1932 by 1932 pixels; retinal fundus photograph:
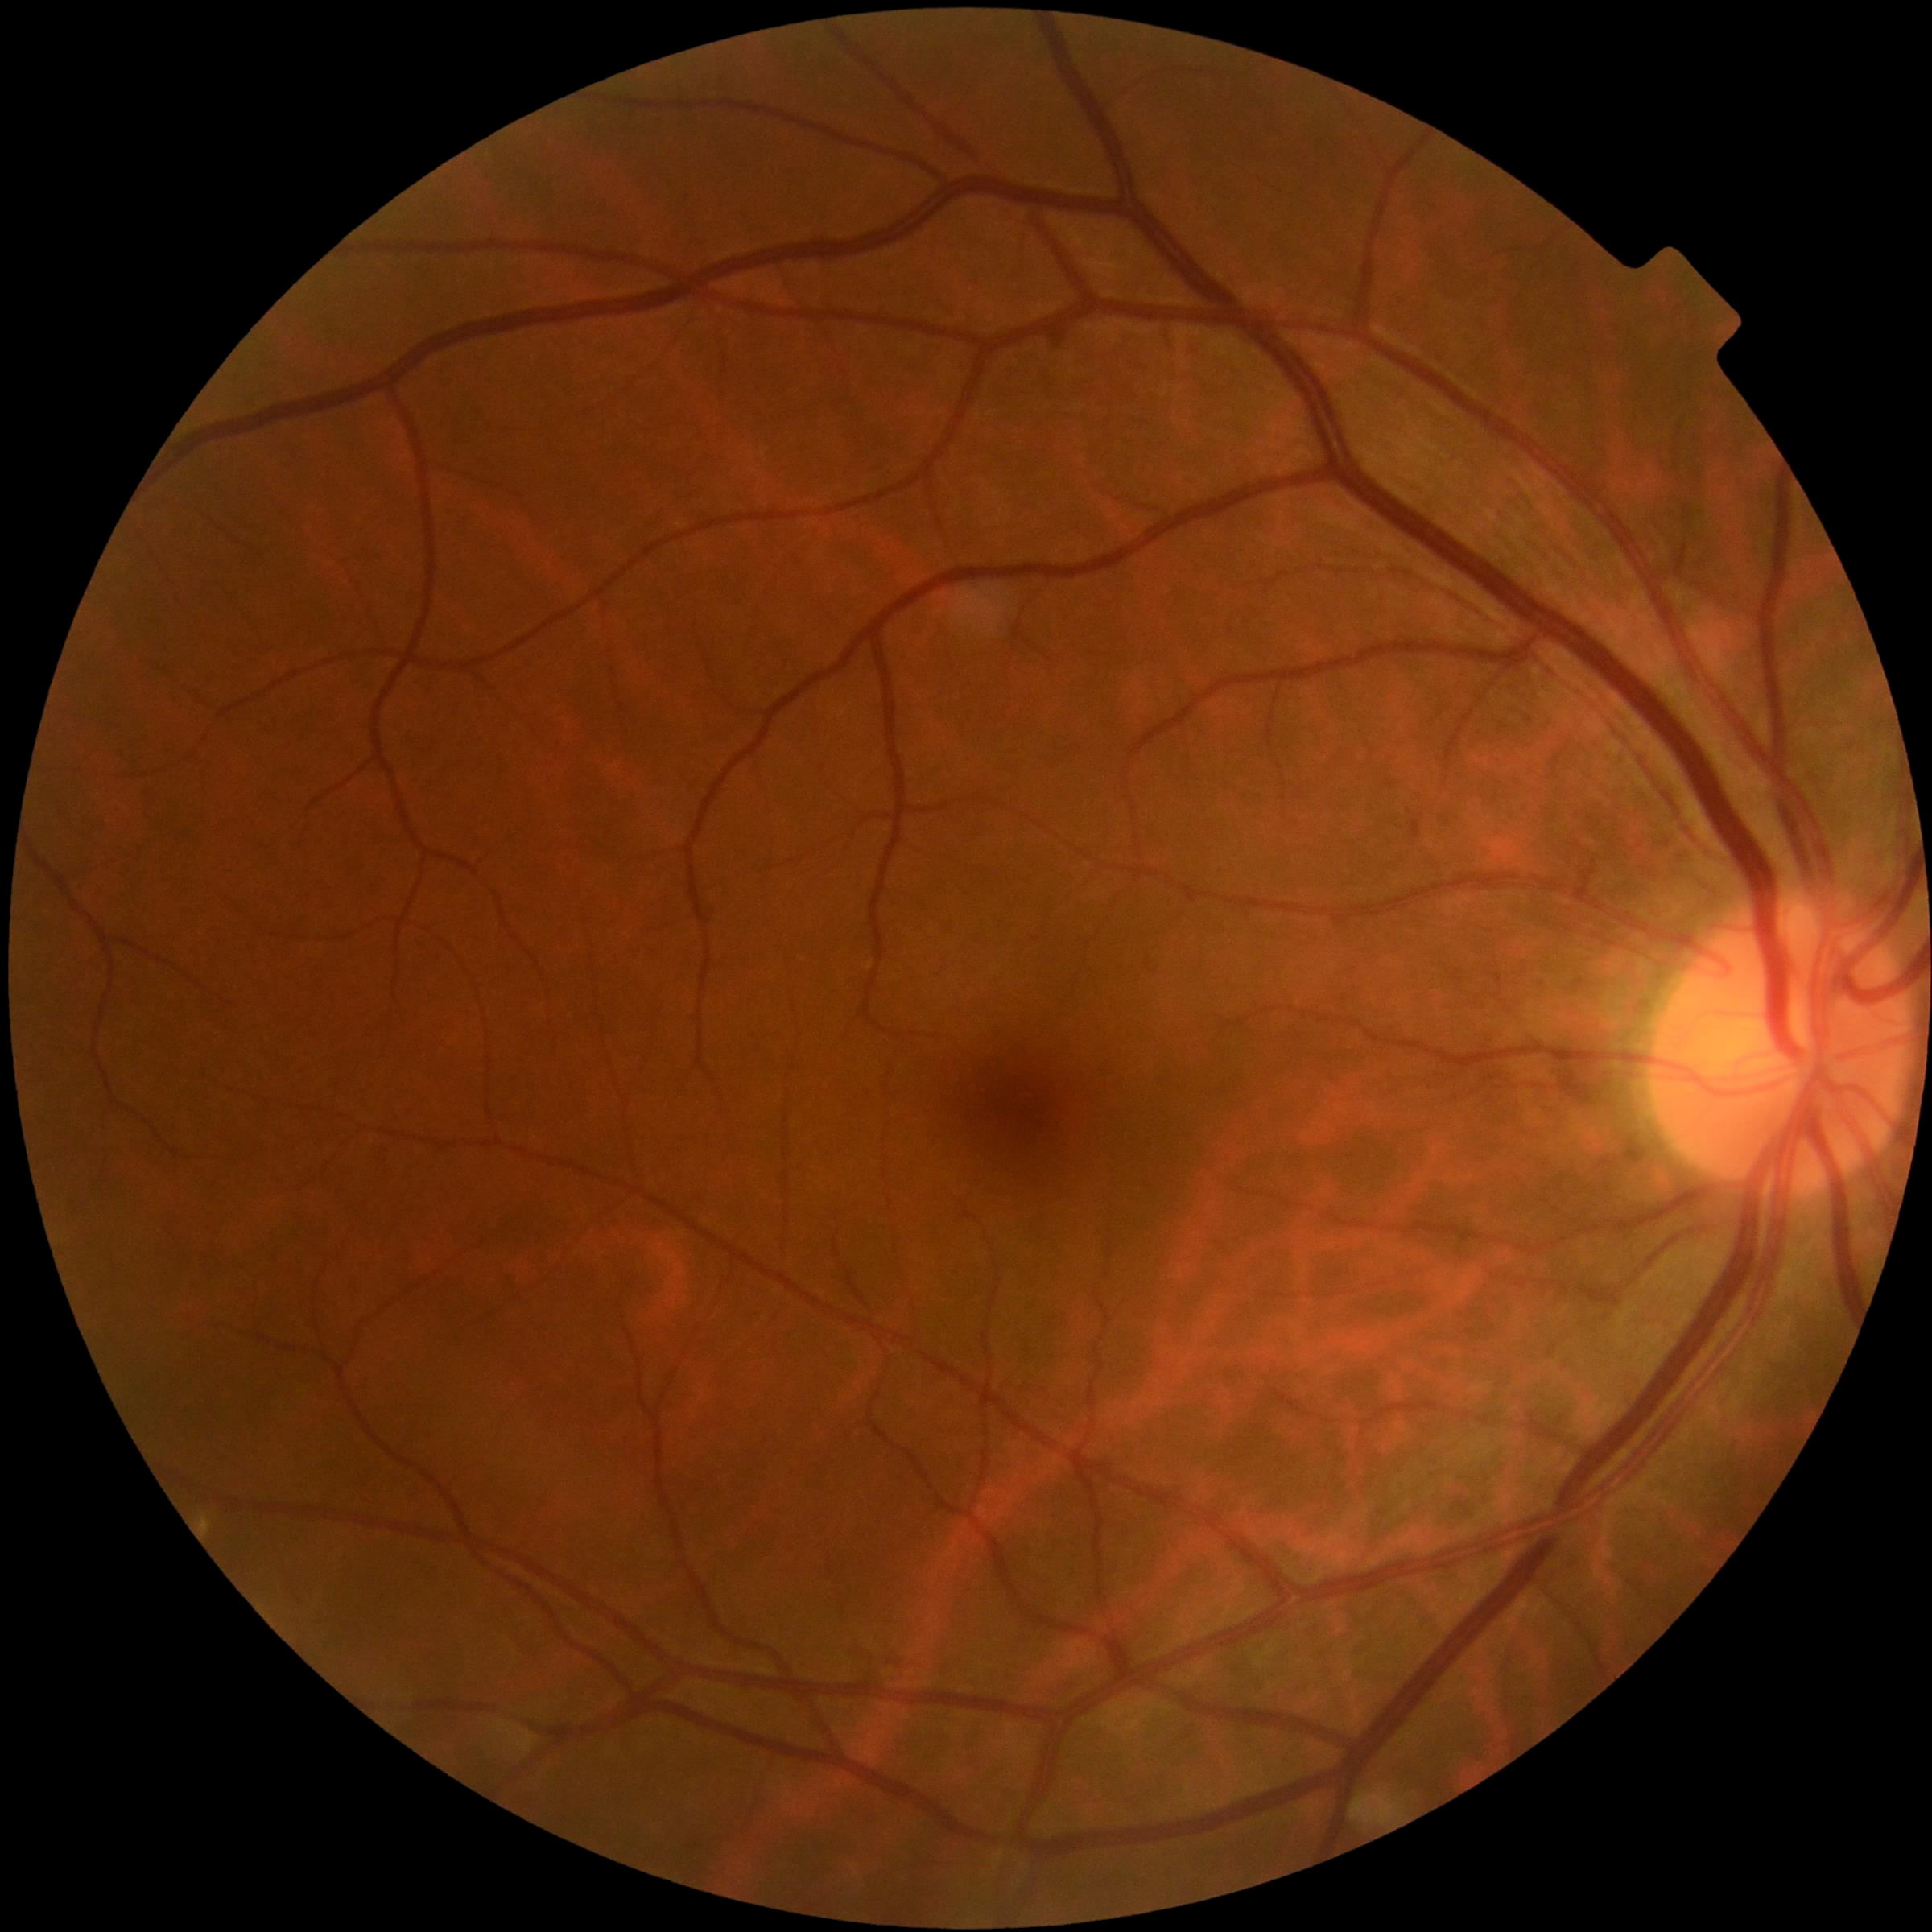 retinopathy = 0 | DR impression = no apparent DR.